No pharmacologic dilation: 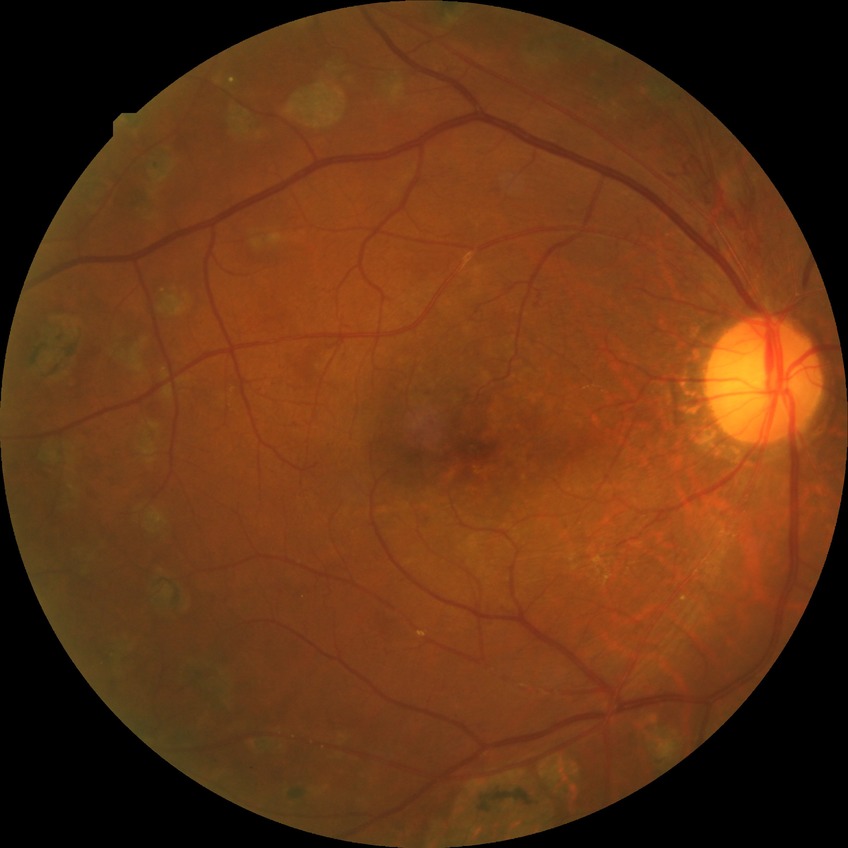

Diabetic retinopathy (DR): proliferative diabetic retinopathy (PDR).